Without pupil dilation. Acquired with a NIDEK AFC-230
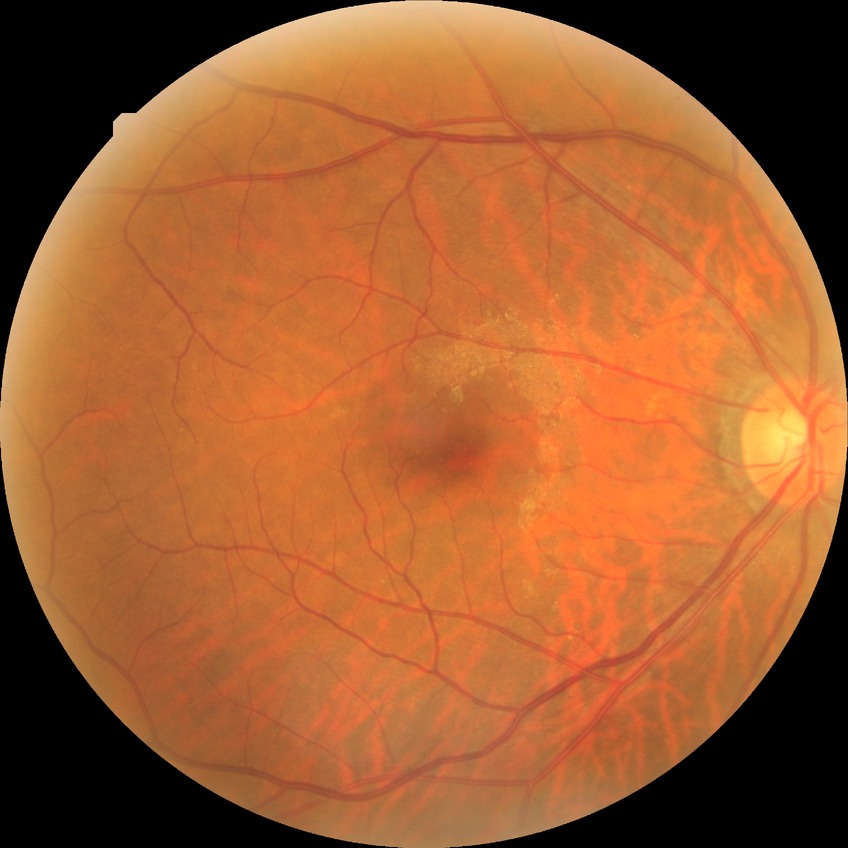 Modified Davis grading is no diabetic retinopathy.